Image size 1920x1440 · captured on a Bosch handheld camera · retinal fundus photograph:
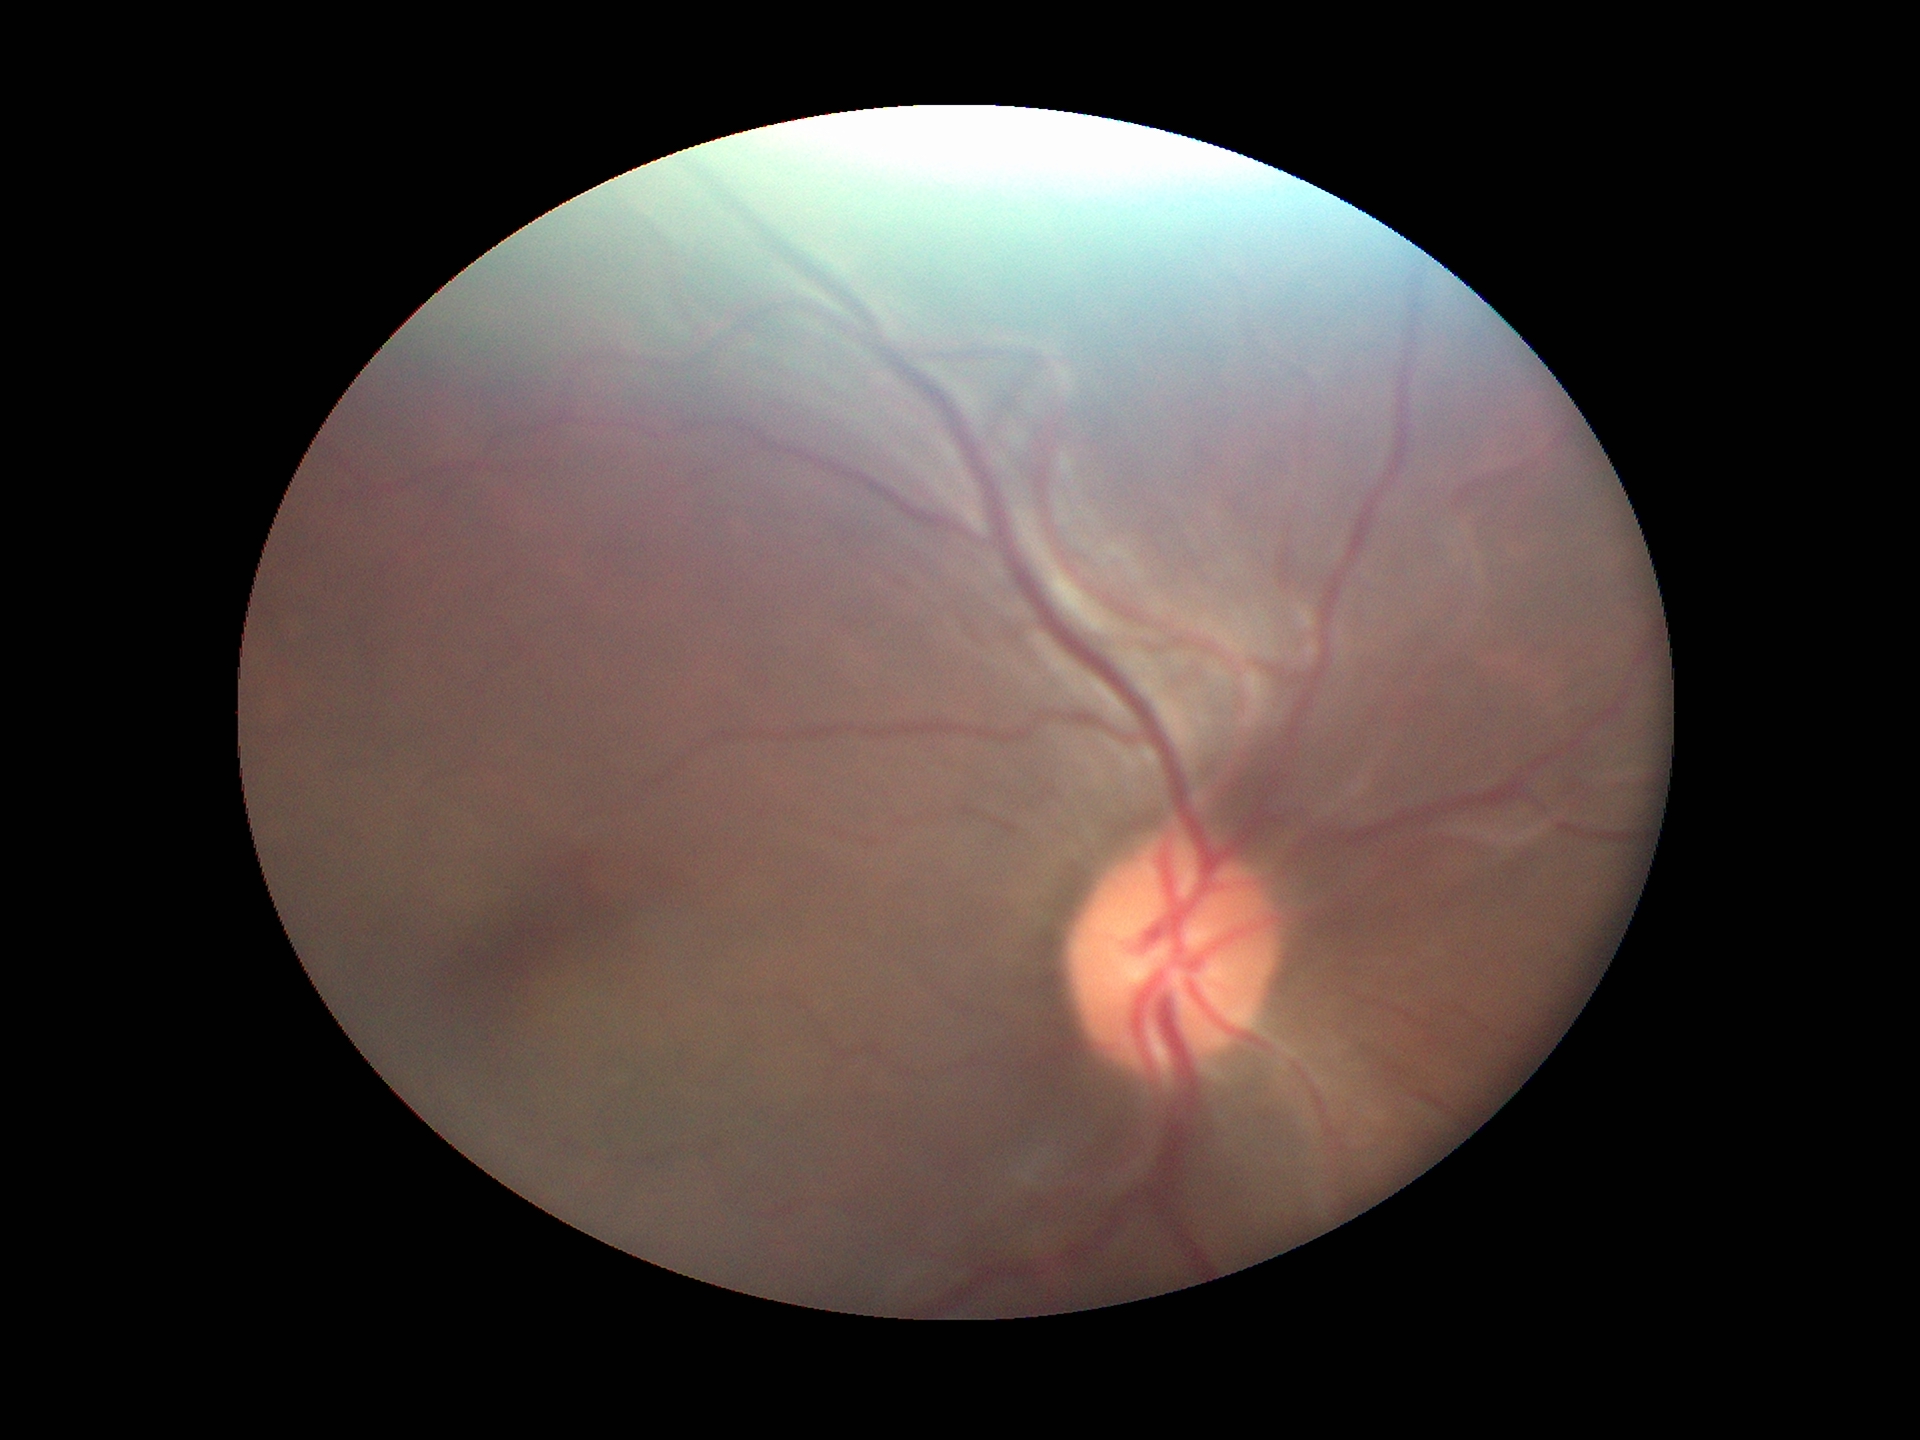

hcdr: 0.46
glaucoma_decision: not suspect
vcdr: 0.46